1240x1240px; Phoenix ICON wide-field infant fundus image.
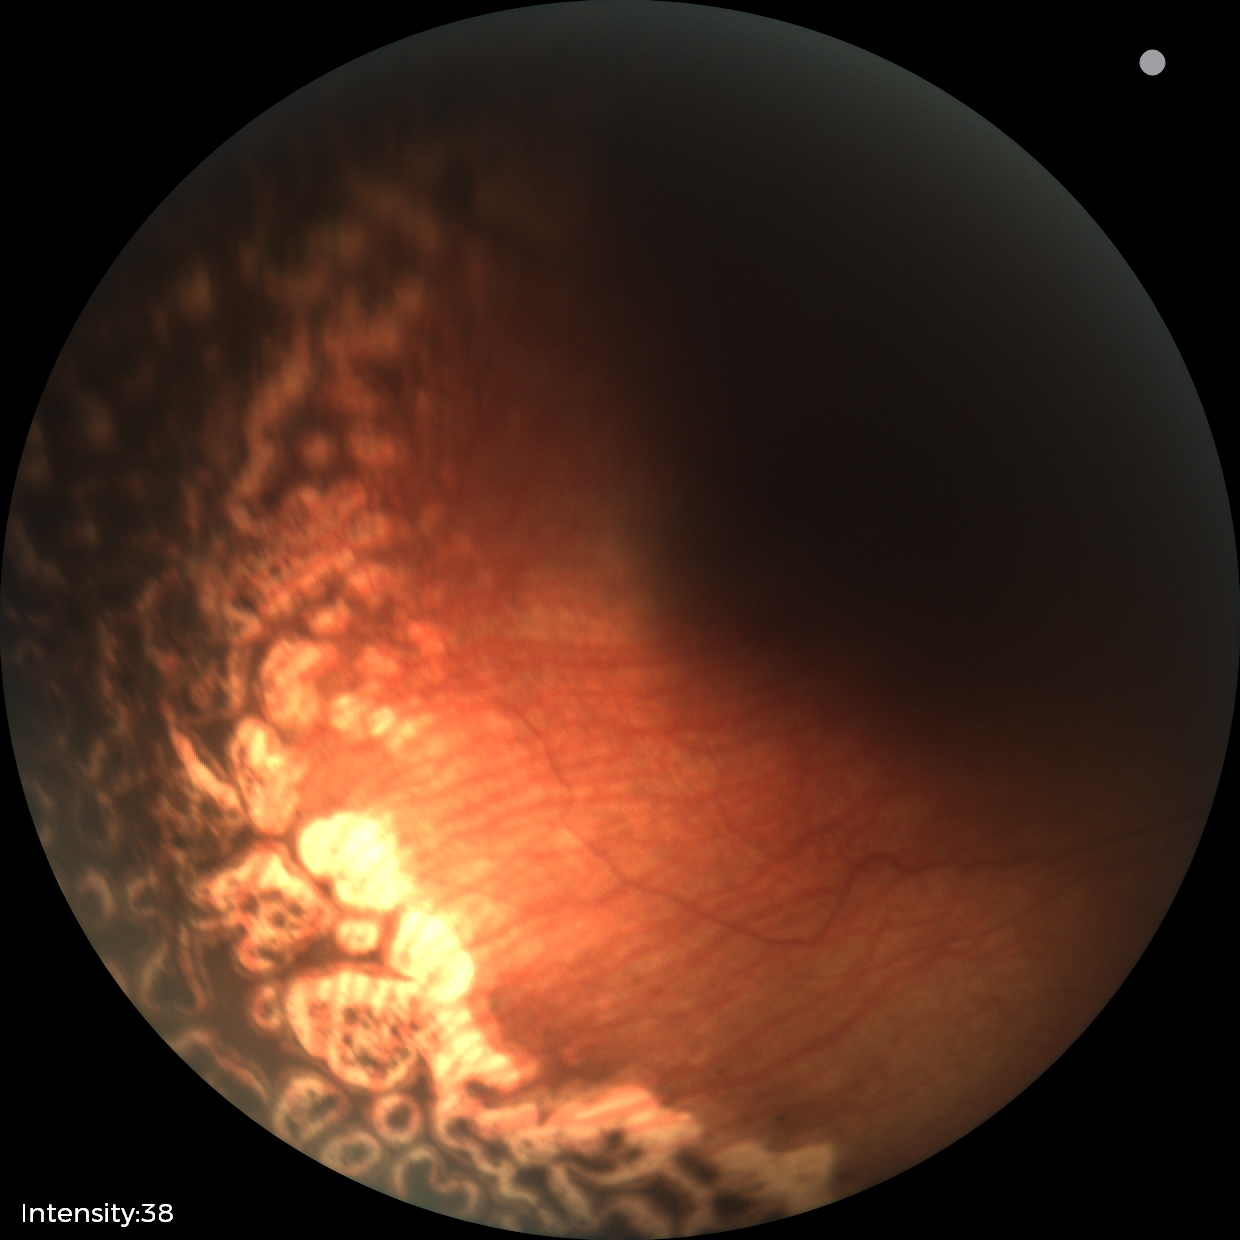
Impression: status post ROP — retinal appearance after treated retinopathy of prematurity | no plus disease.